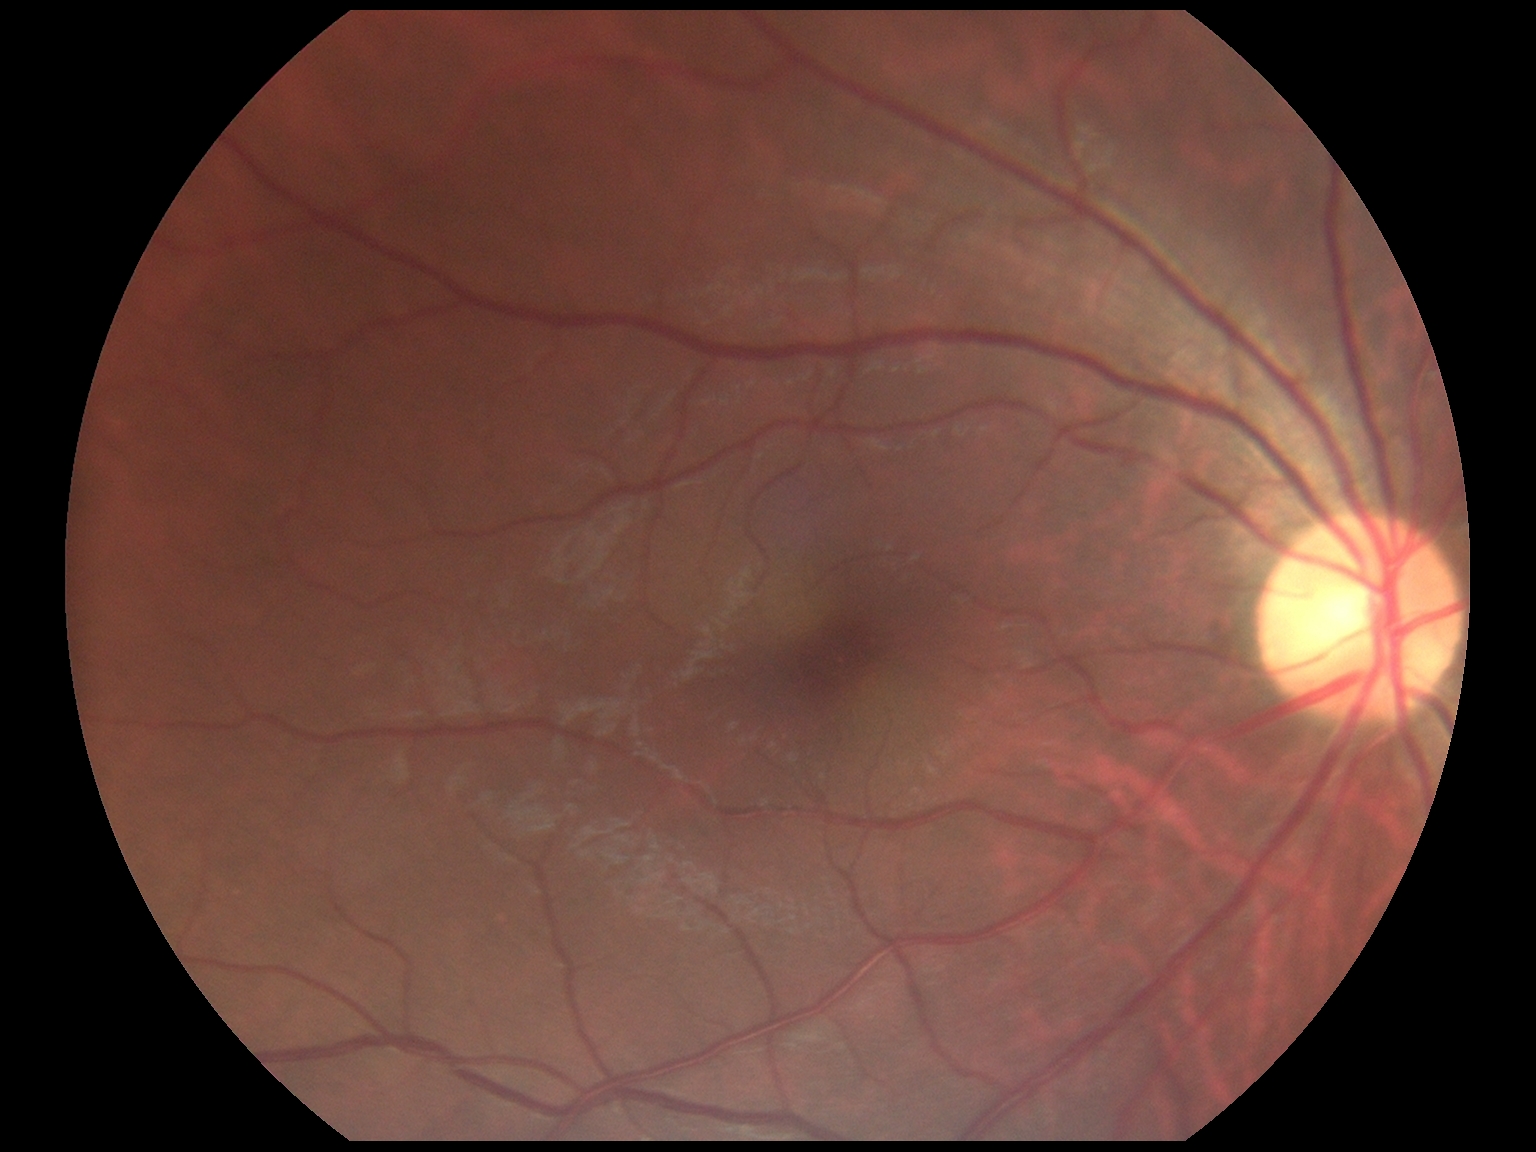

No apparent diabetic retinopathy.
Diabetic retinopathy (DR): grade 0 (no apparent retinopathy).